Wide-field fundus image from infant ROP screening — 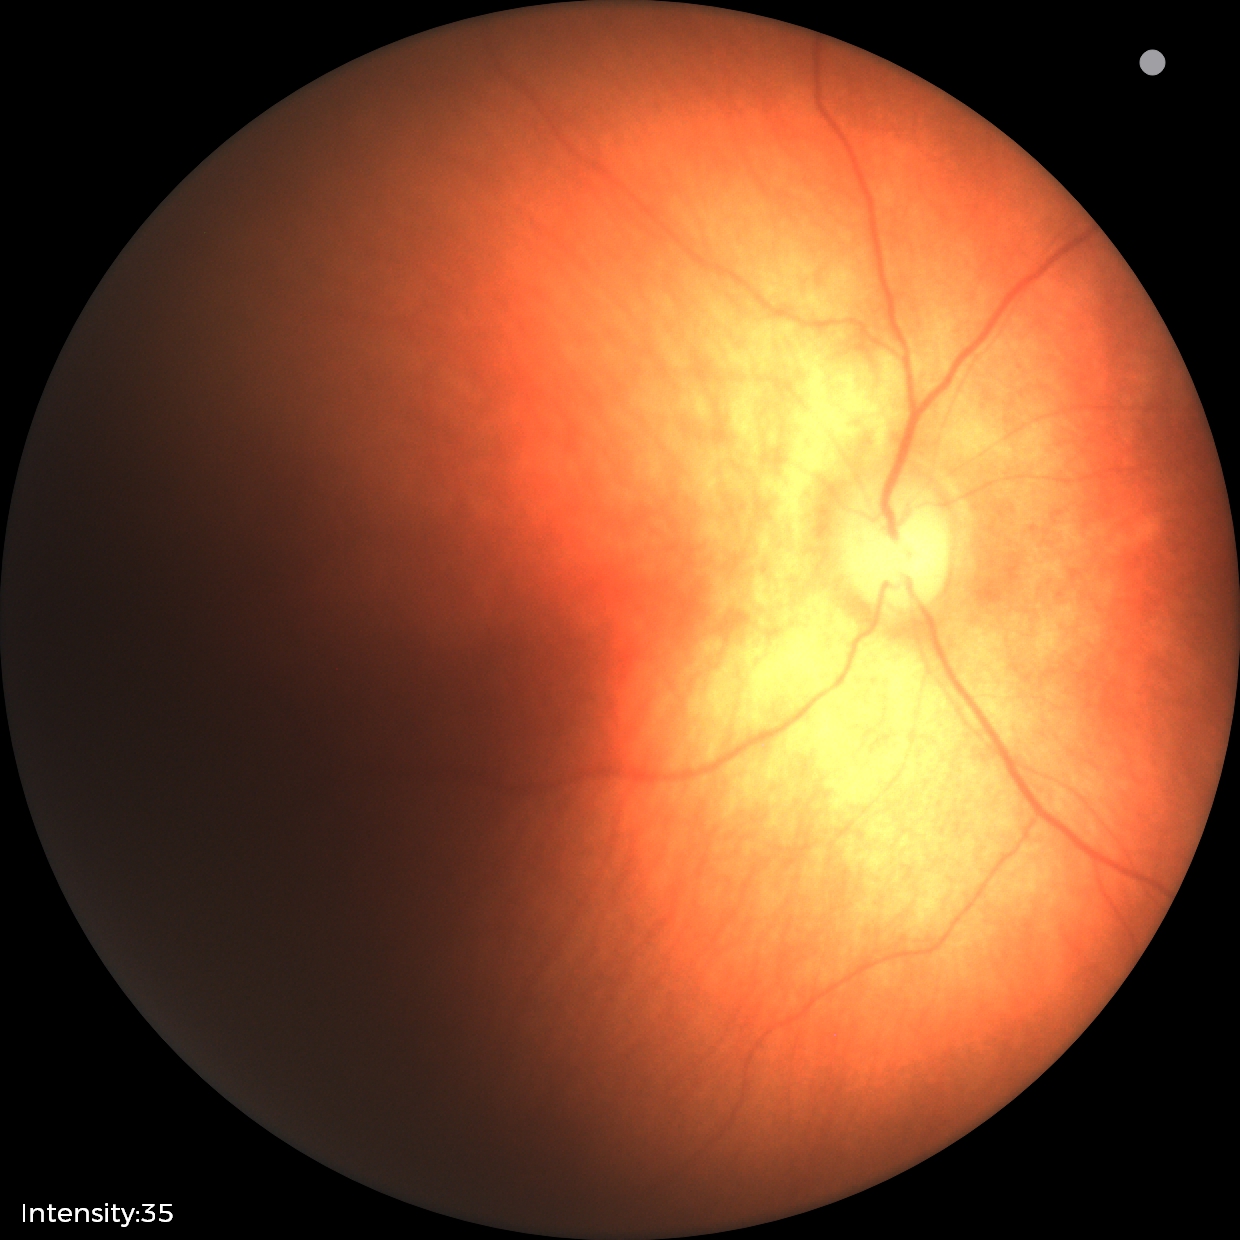 Normal screening examination.